412x310px, color fundus image, 45-degree field of view
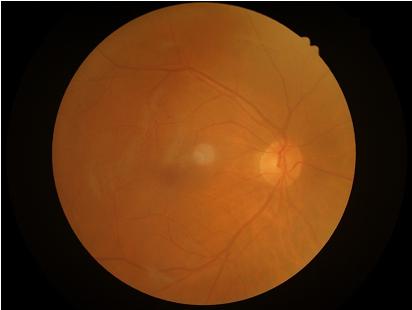 Image quality assessment: sharpness: clear with no noticeable blur | illumination: uniform, no color cast | overall: good and suitable for diagnostic use | contrast: vessels and details readily distinguishable.